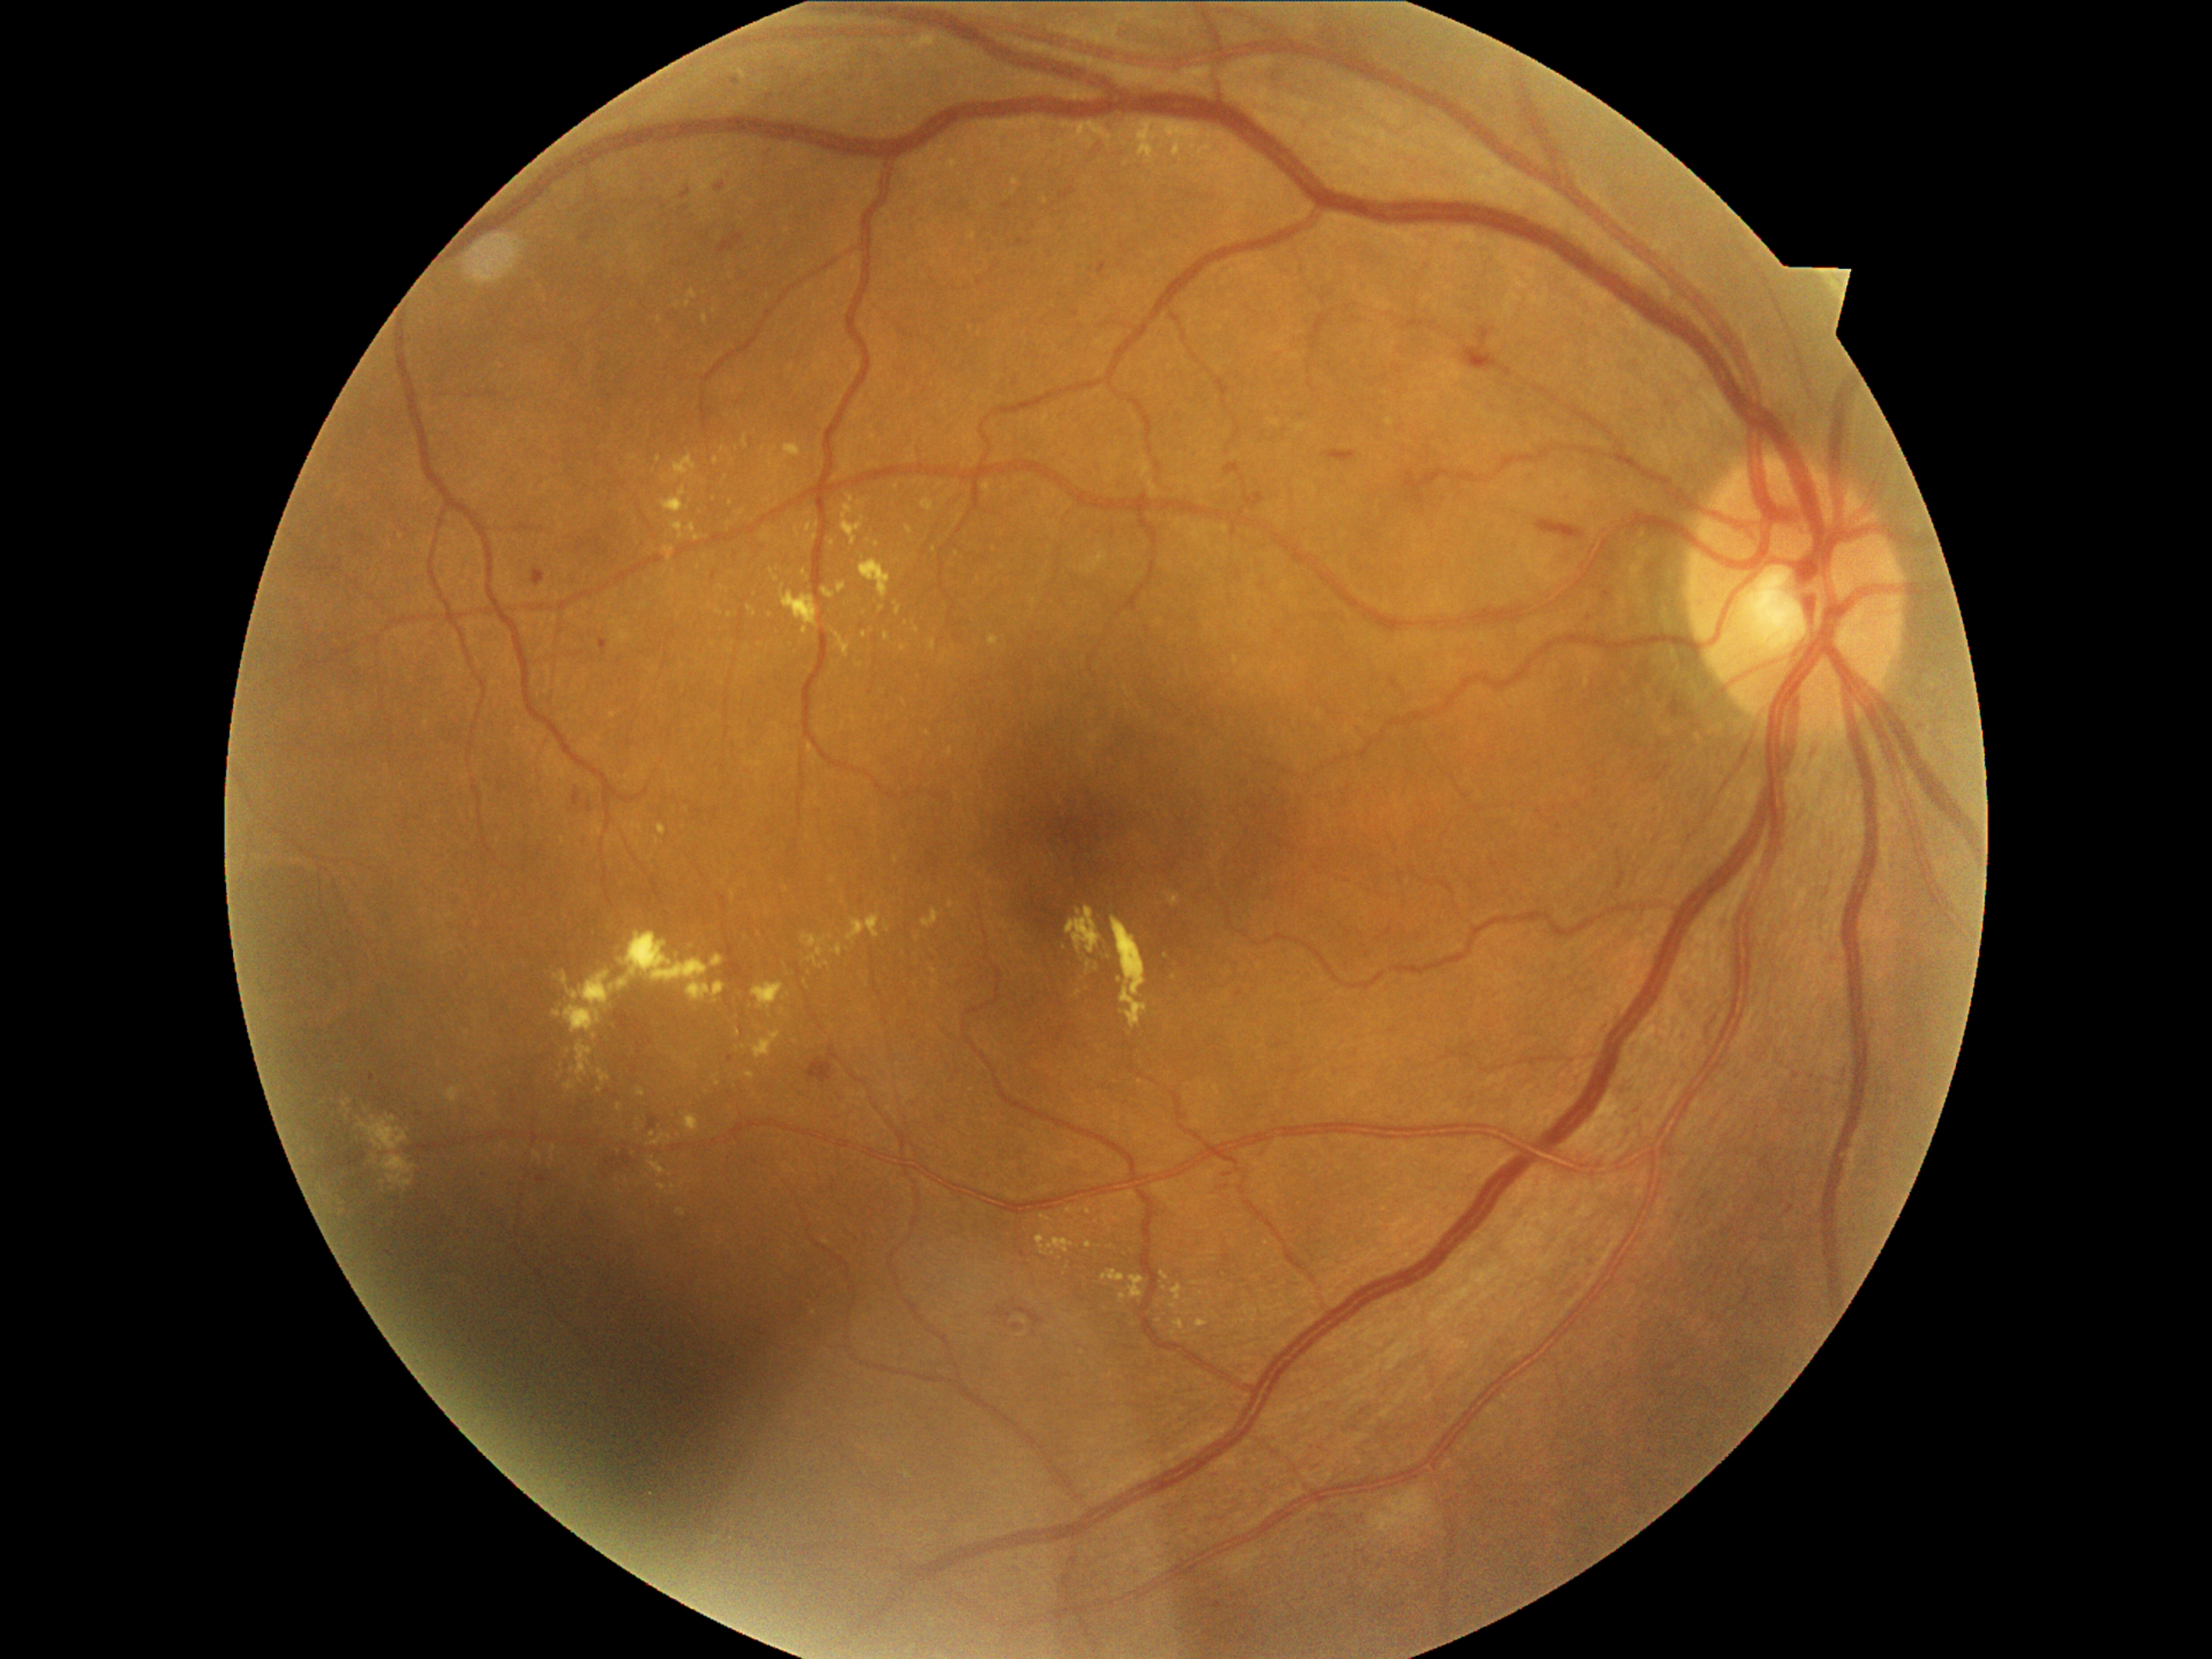 <lesions partial="true">
  <dr_grade>2</dr_grade>
  <ex partial="true">box=[446, 1086, 465, 1103], box=[747, 607, 757, 617], box=[573, 1040, 593, 1081], box=[663, 475, 668, 486], box=[1161, 1272, 1170, 1281], box=[658, 825, 667, 835], box=[381, 1156, 416, 1190], box=[796, 528, 801, 537], box=[711, 955, 725, 969], box=[637, 1090, 646, 1097], box=[769, 569, 779, 581]</ex>
  <ex_small>[x=730, y=616], [x=738, y=1033], [x=714, y=311], [x=716, y=461], [x=941, y=484], [x=934, y=984], [x=907, y=624]</ex_small>
</lesions>